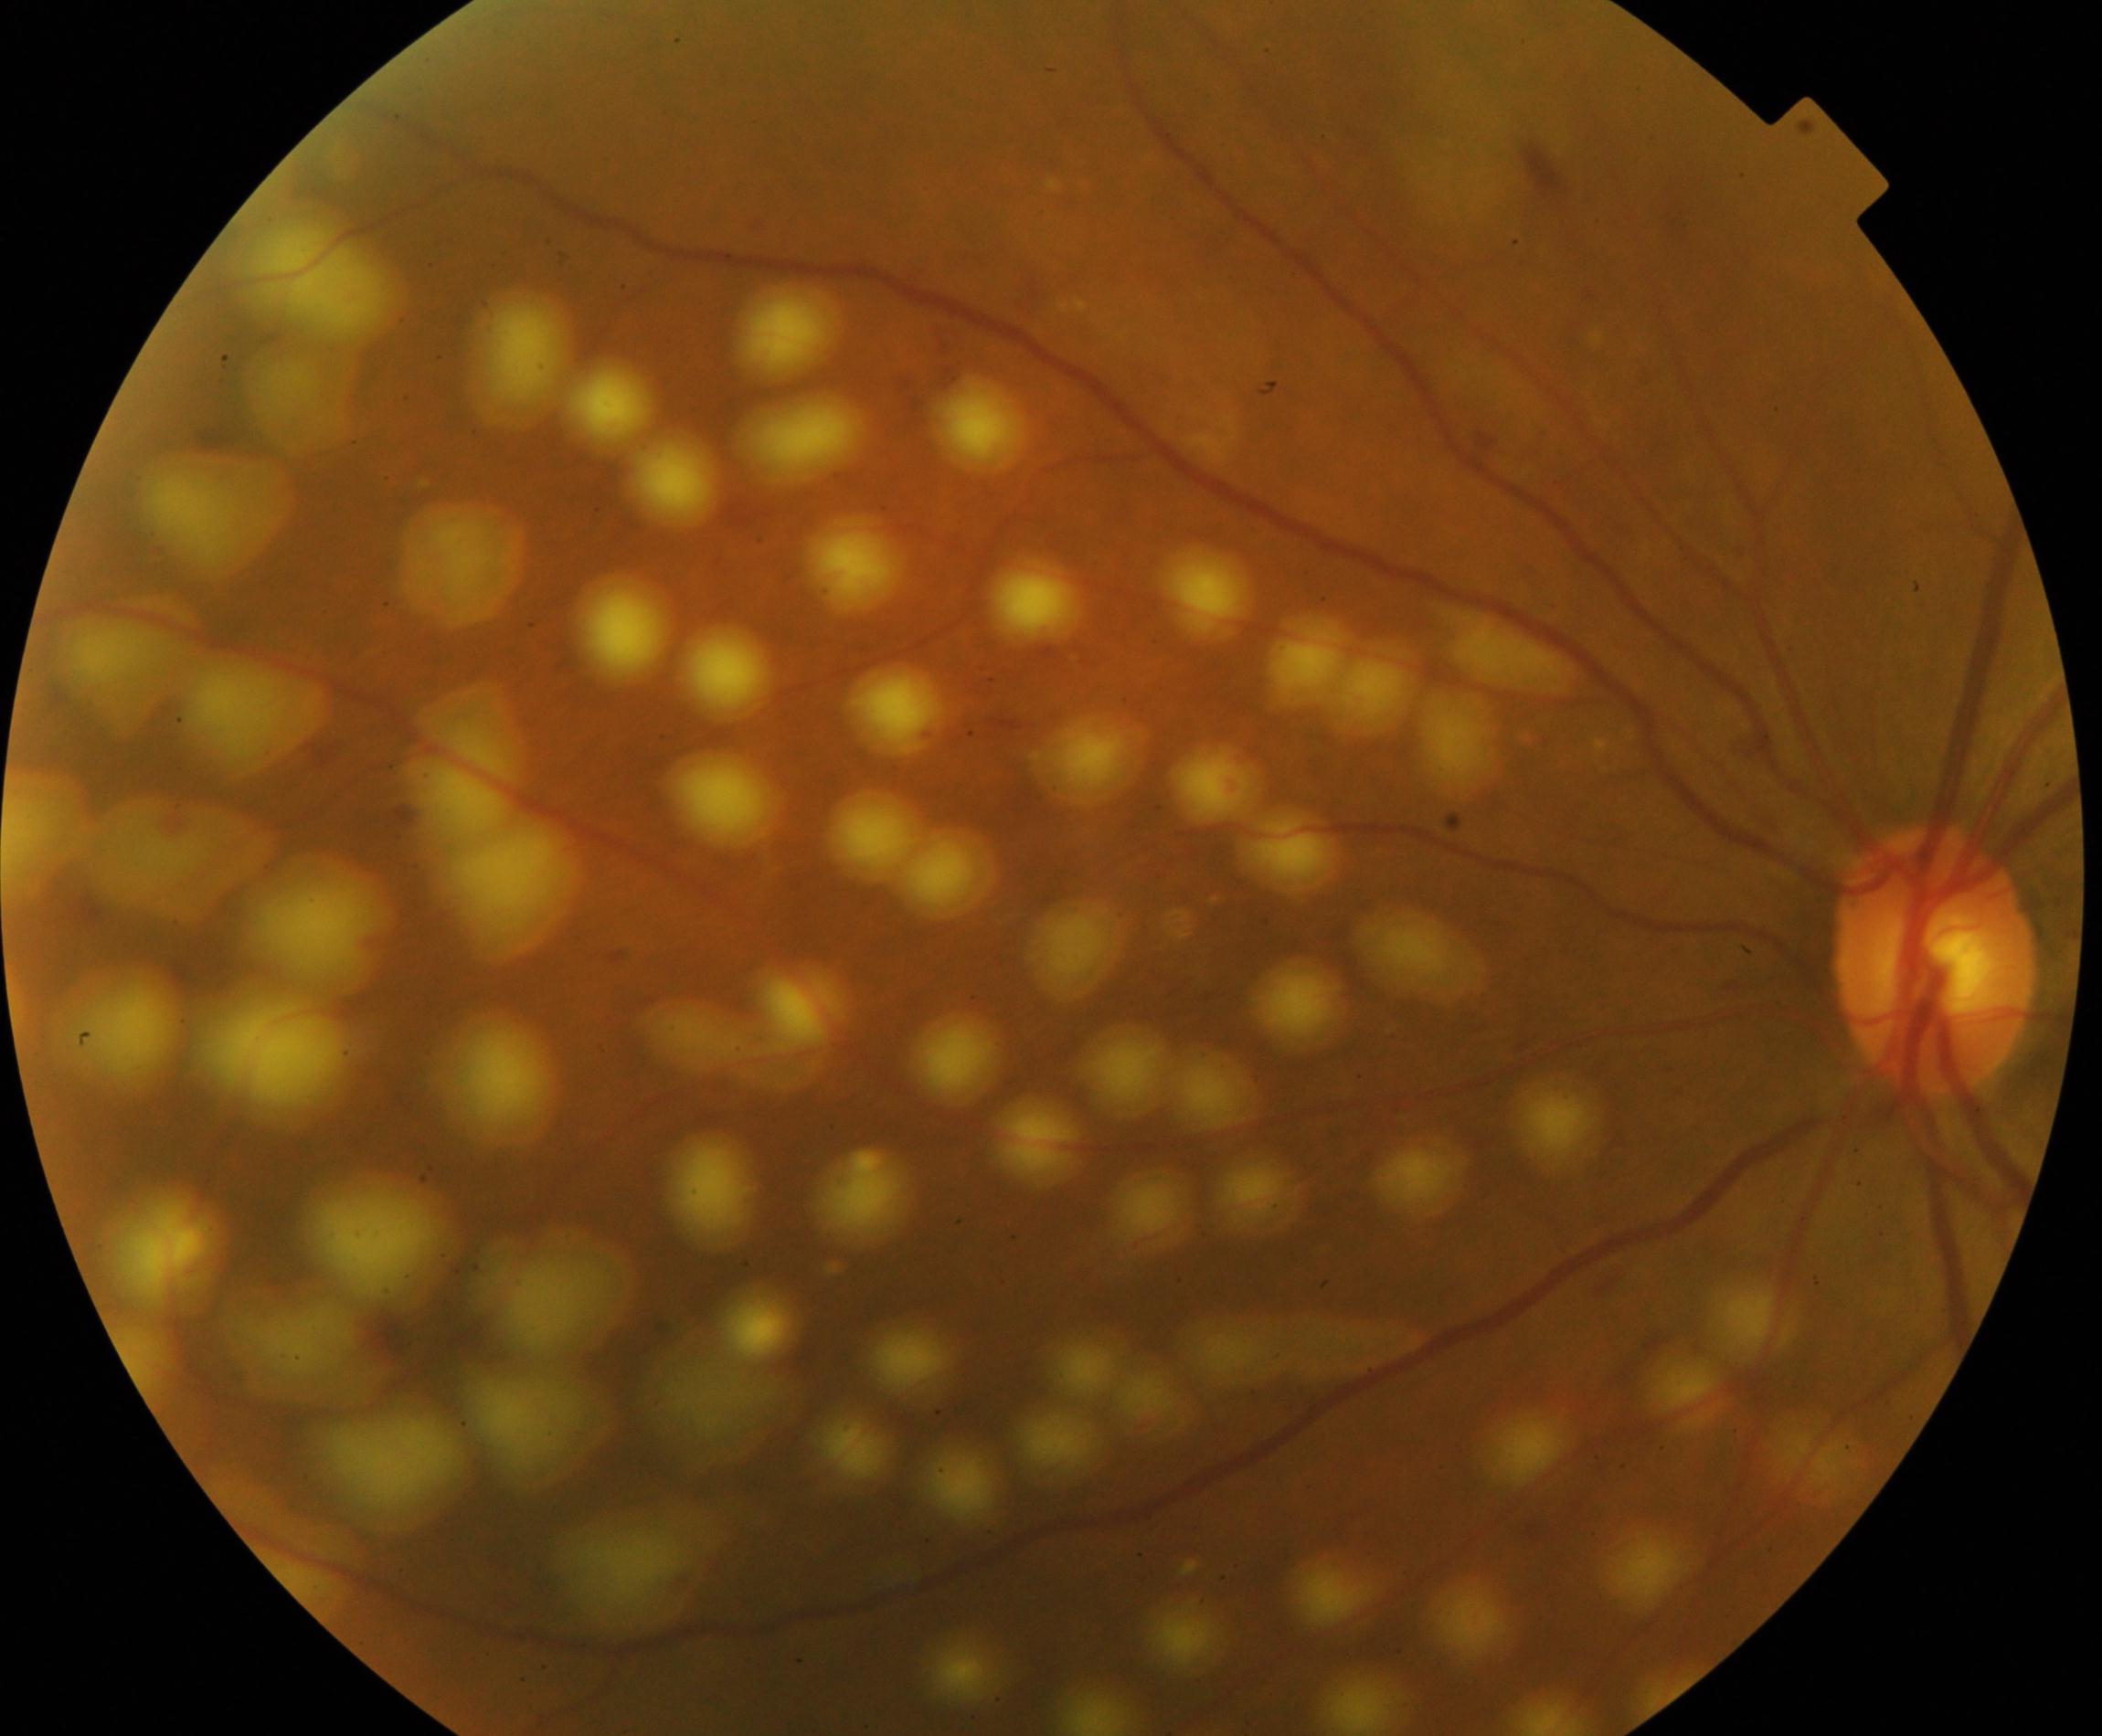 Color fundus photograph showing laser spots.